Axial length 22.35 mm · 2212 x 1661 pixels.
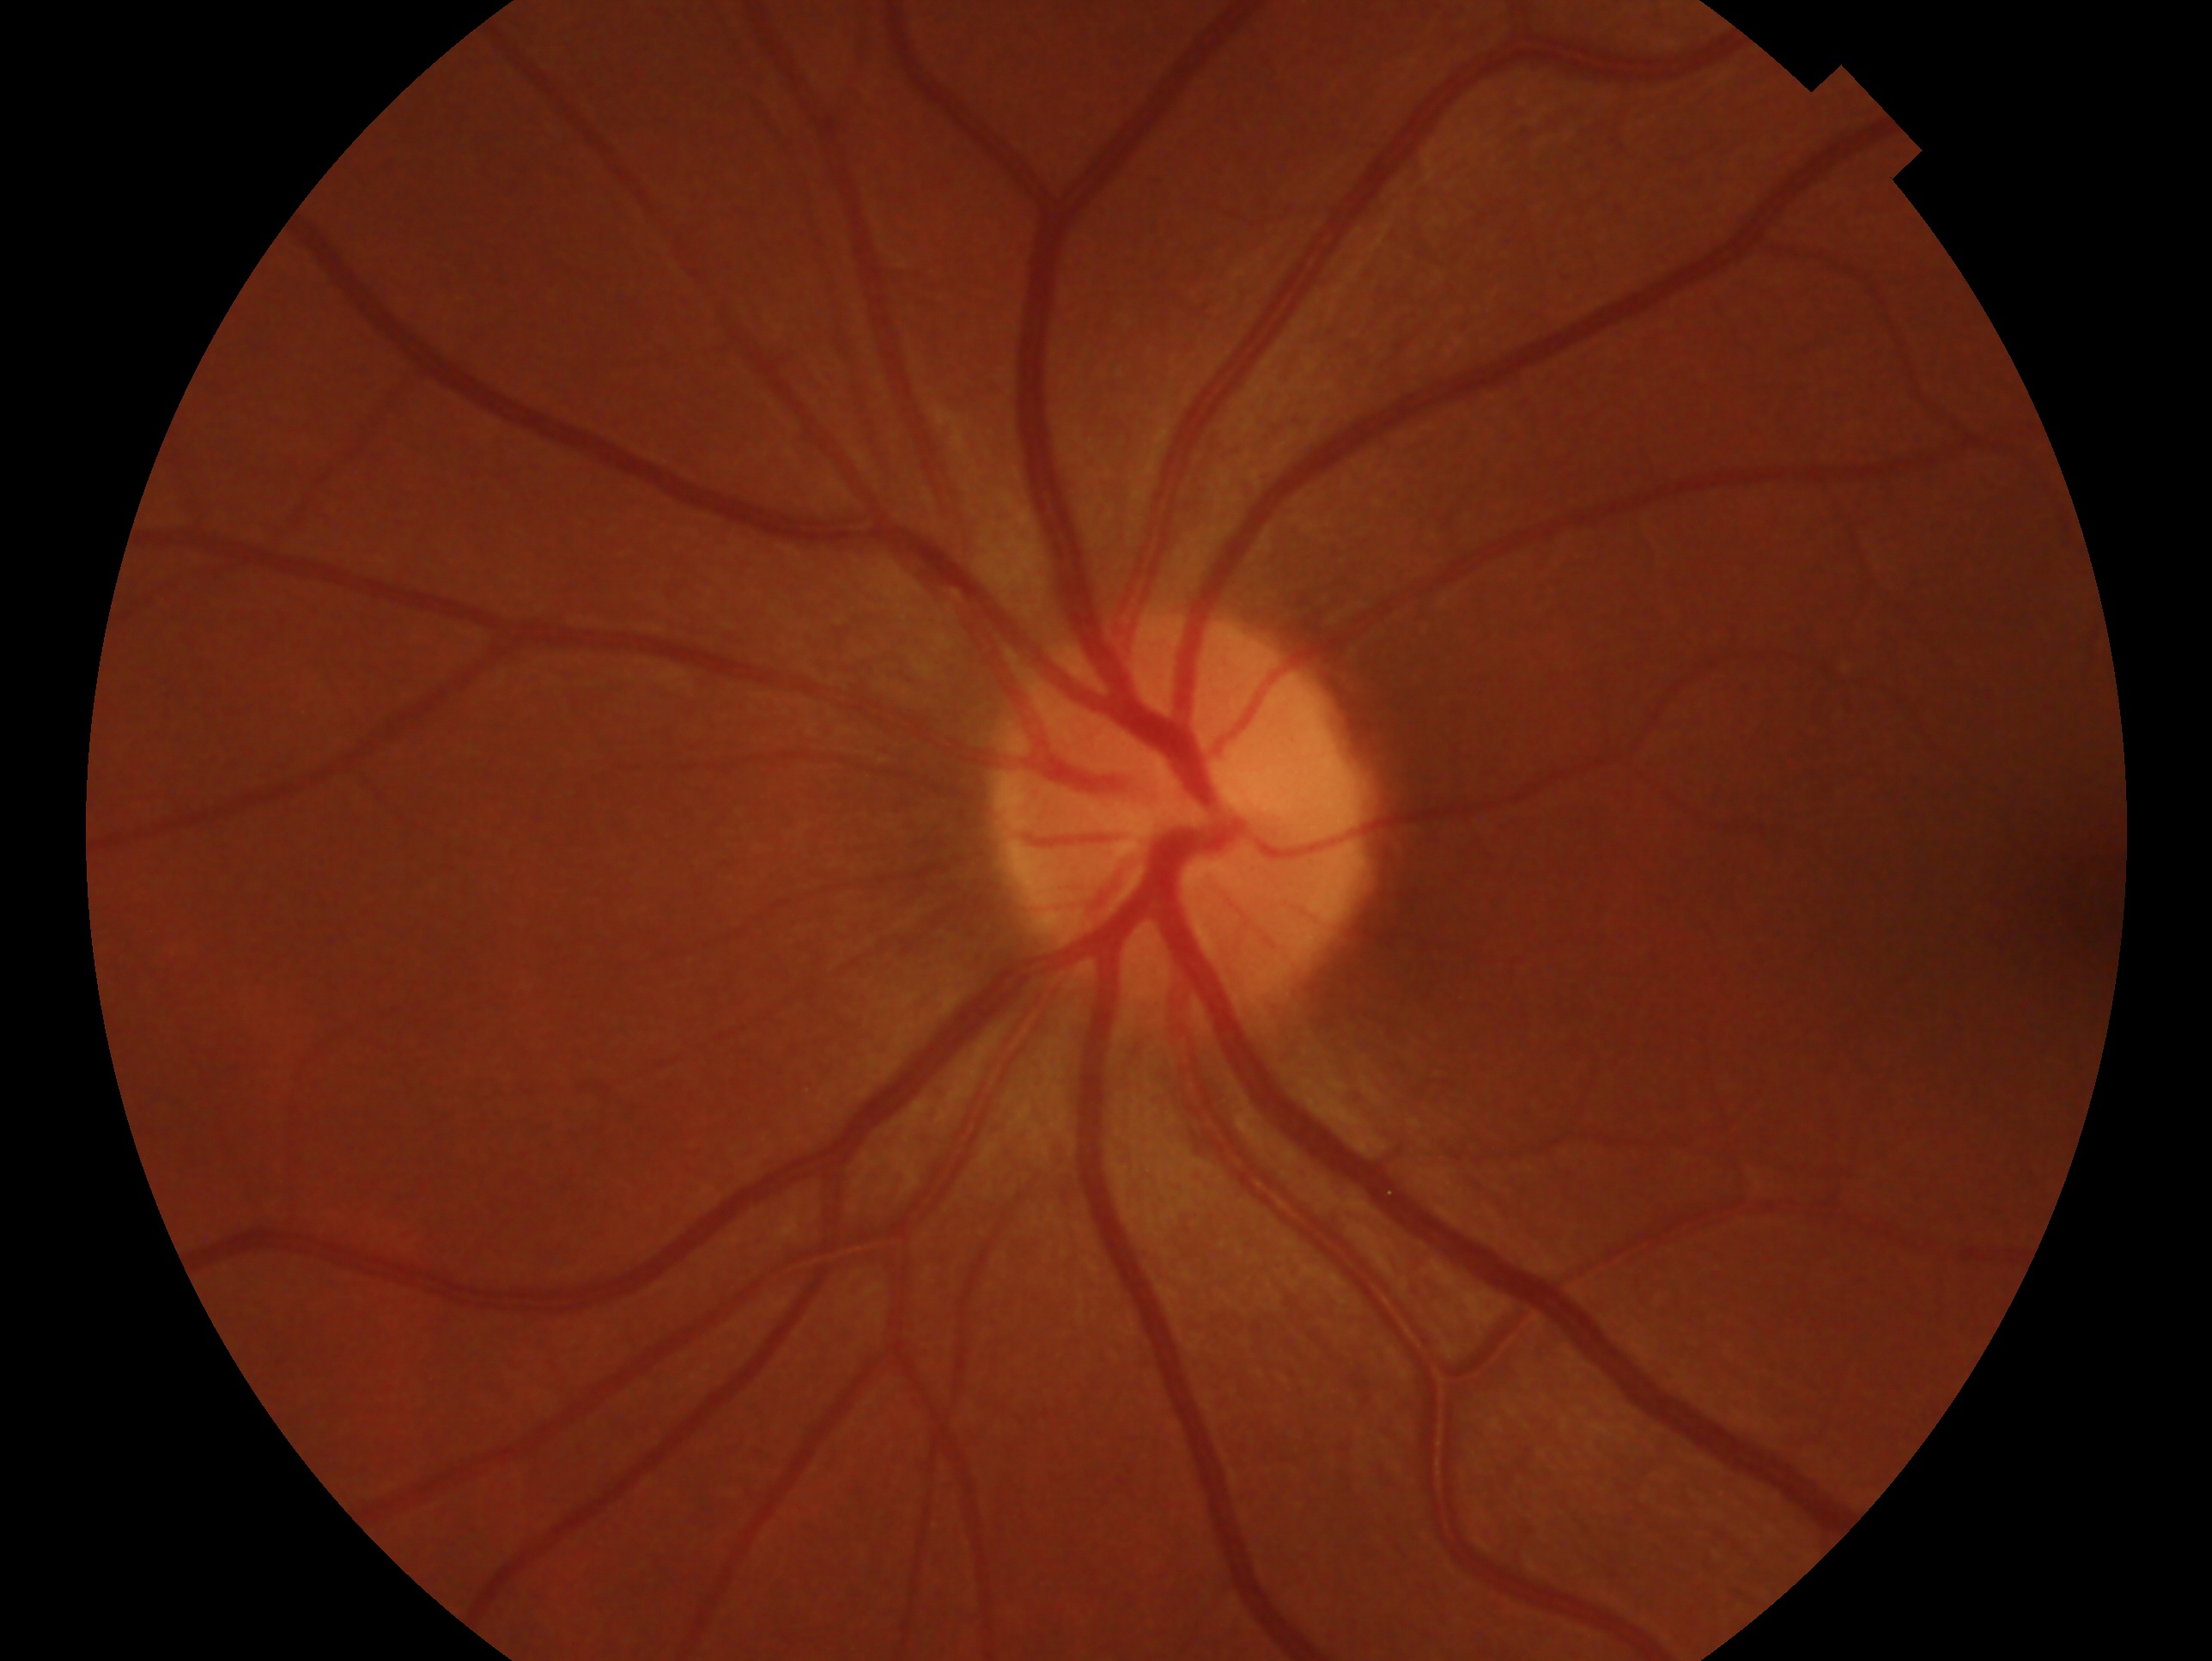 Glaucoma assessment — no glaucomatous findings.
This is the left eye.